Color fundus photograph, 45° field of view:
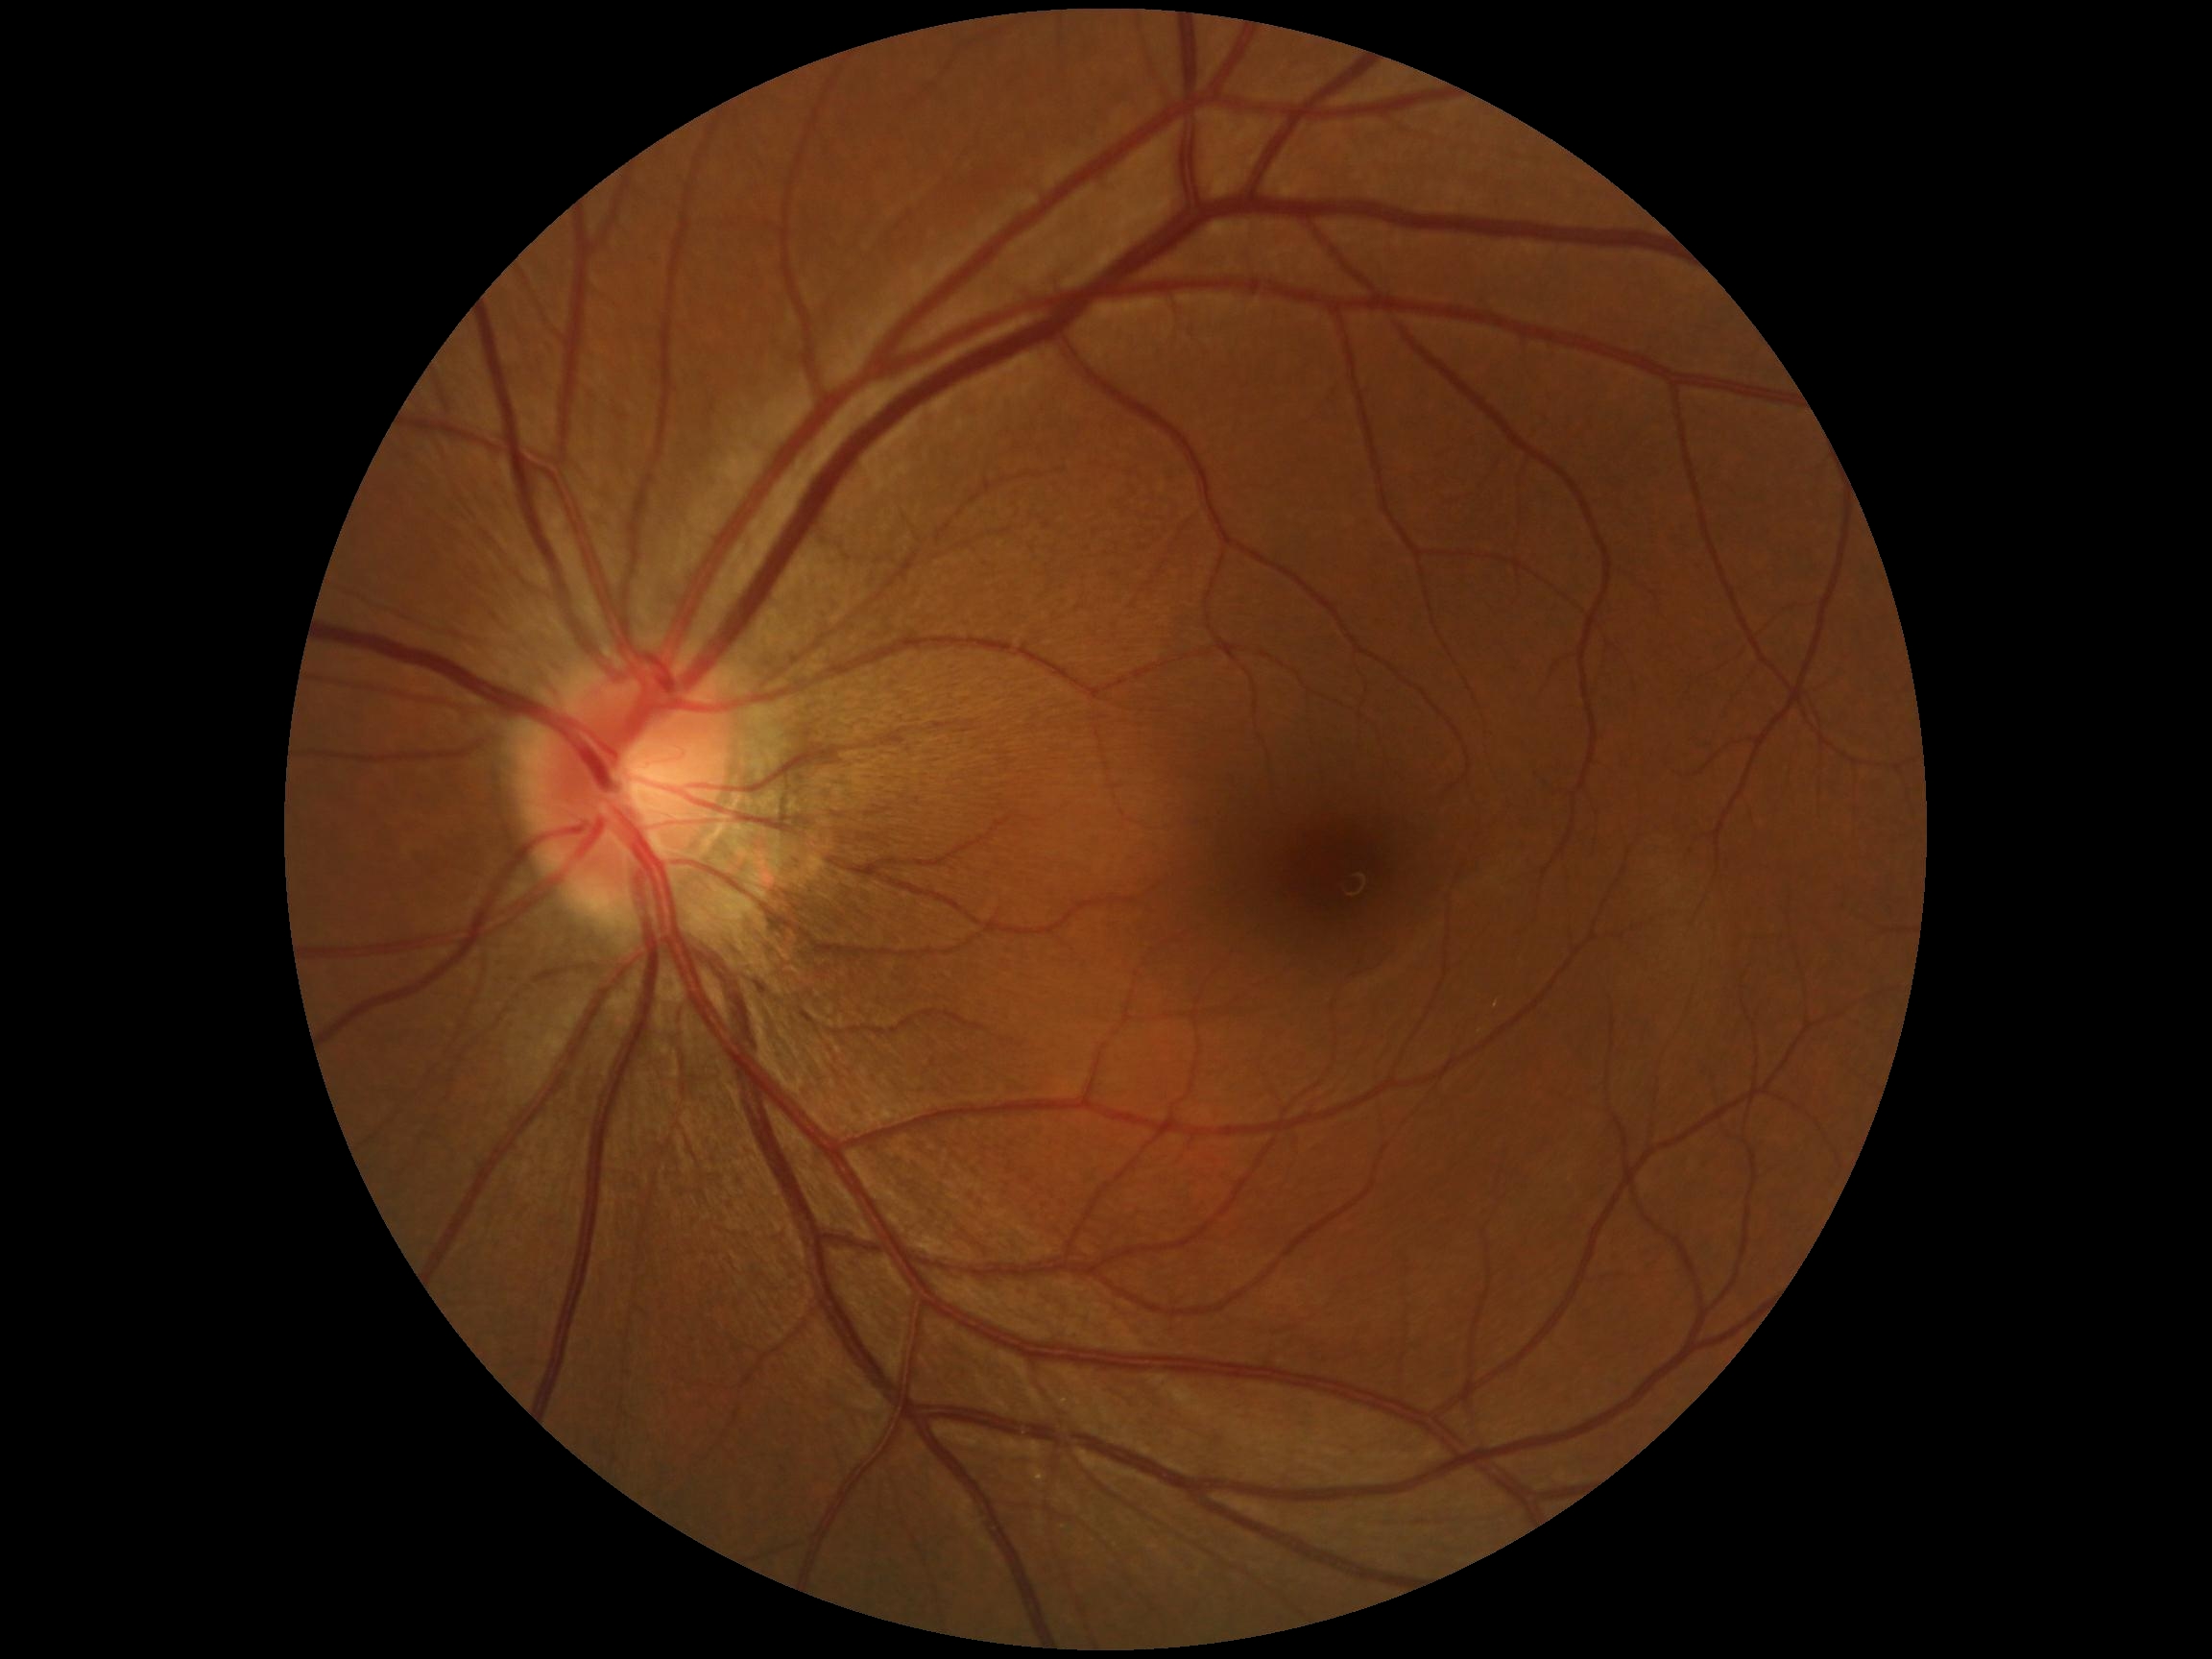 Annotations:
– DR stage — 0/4